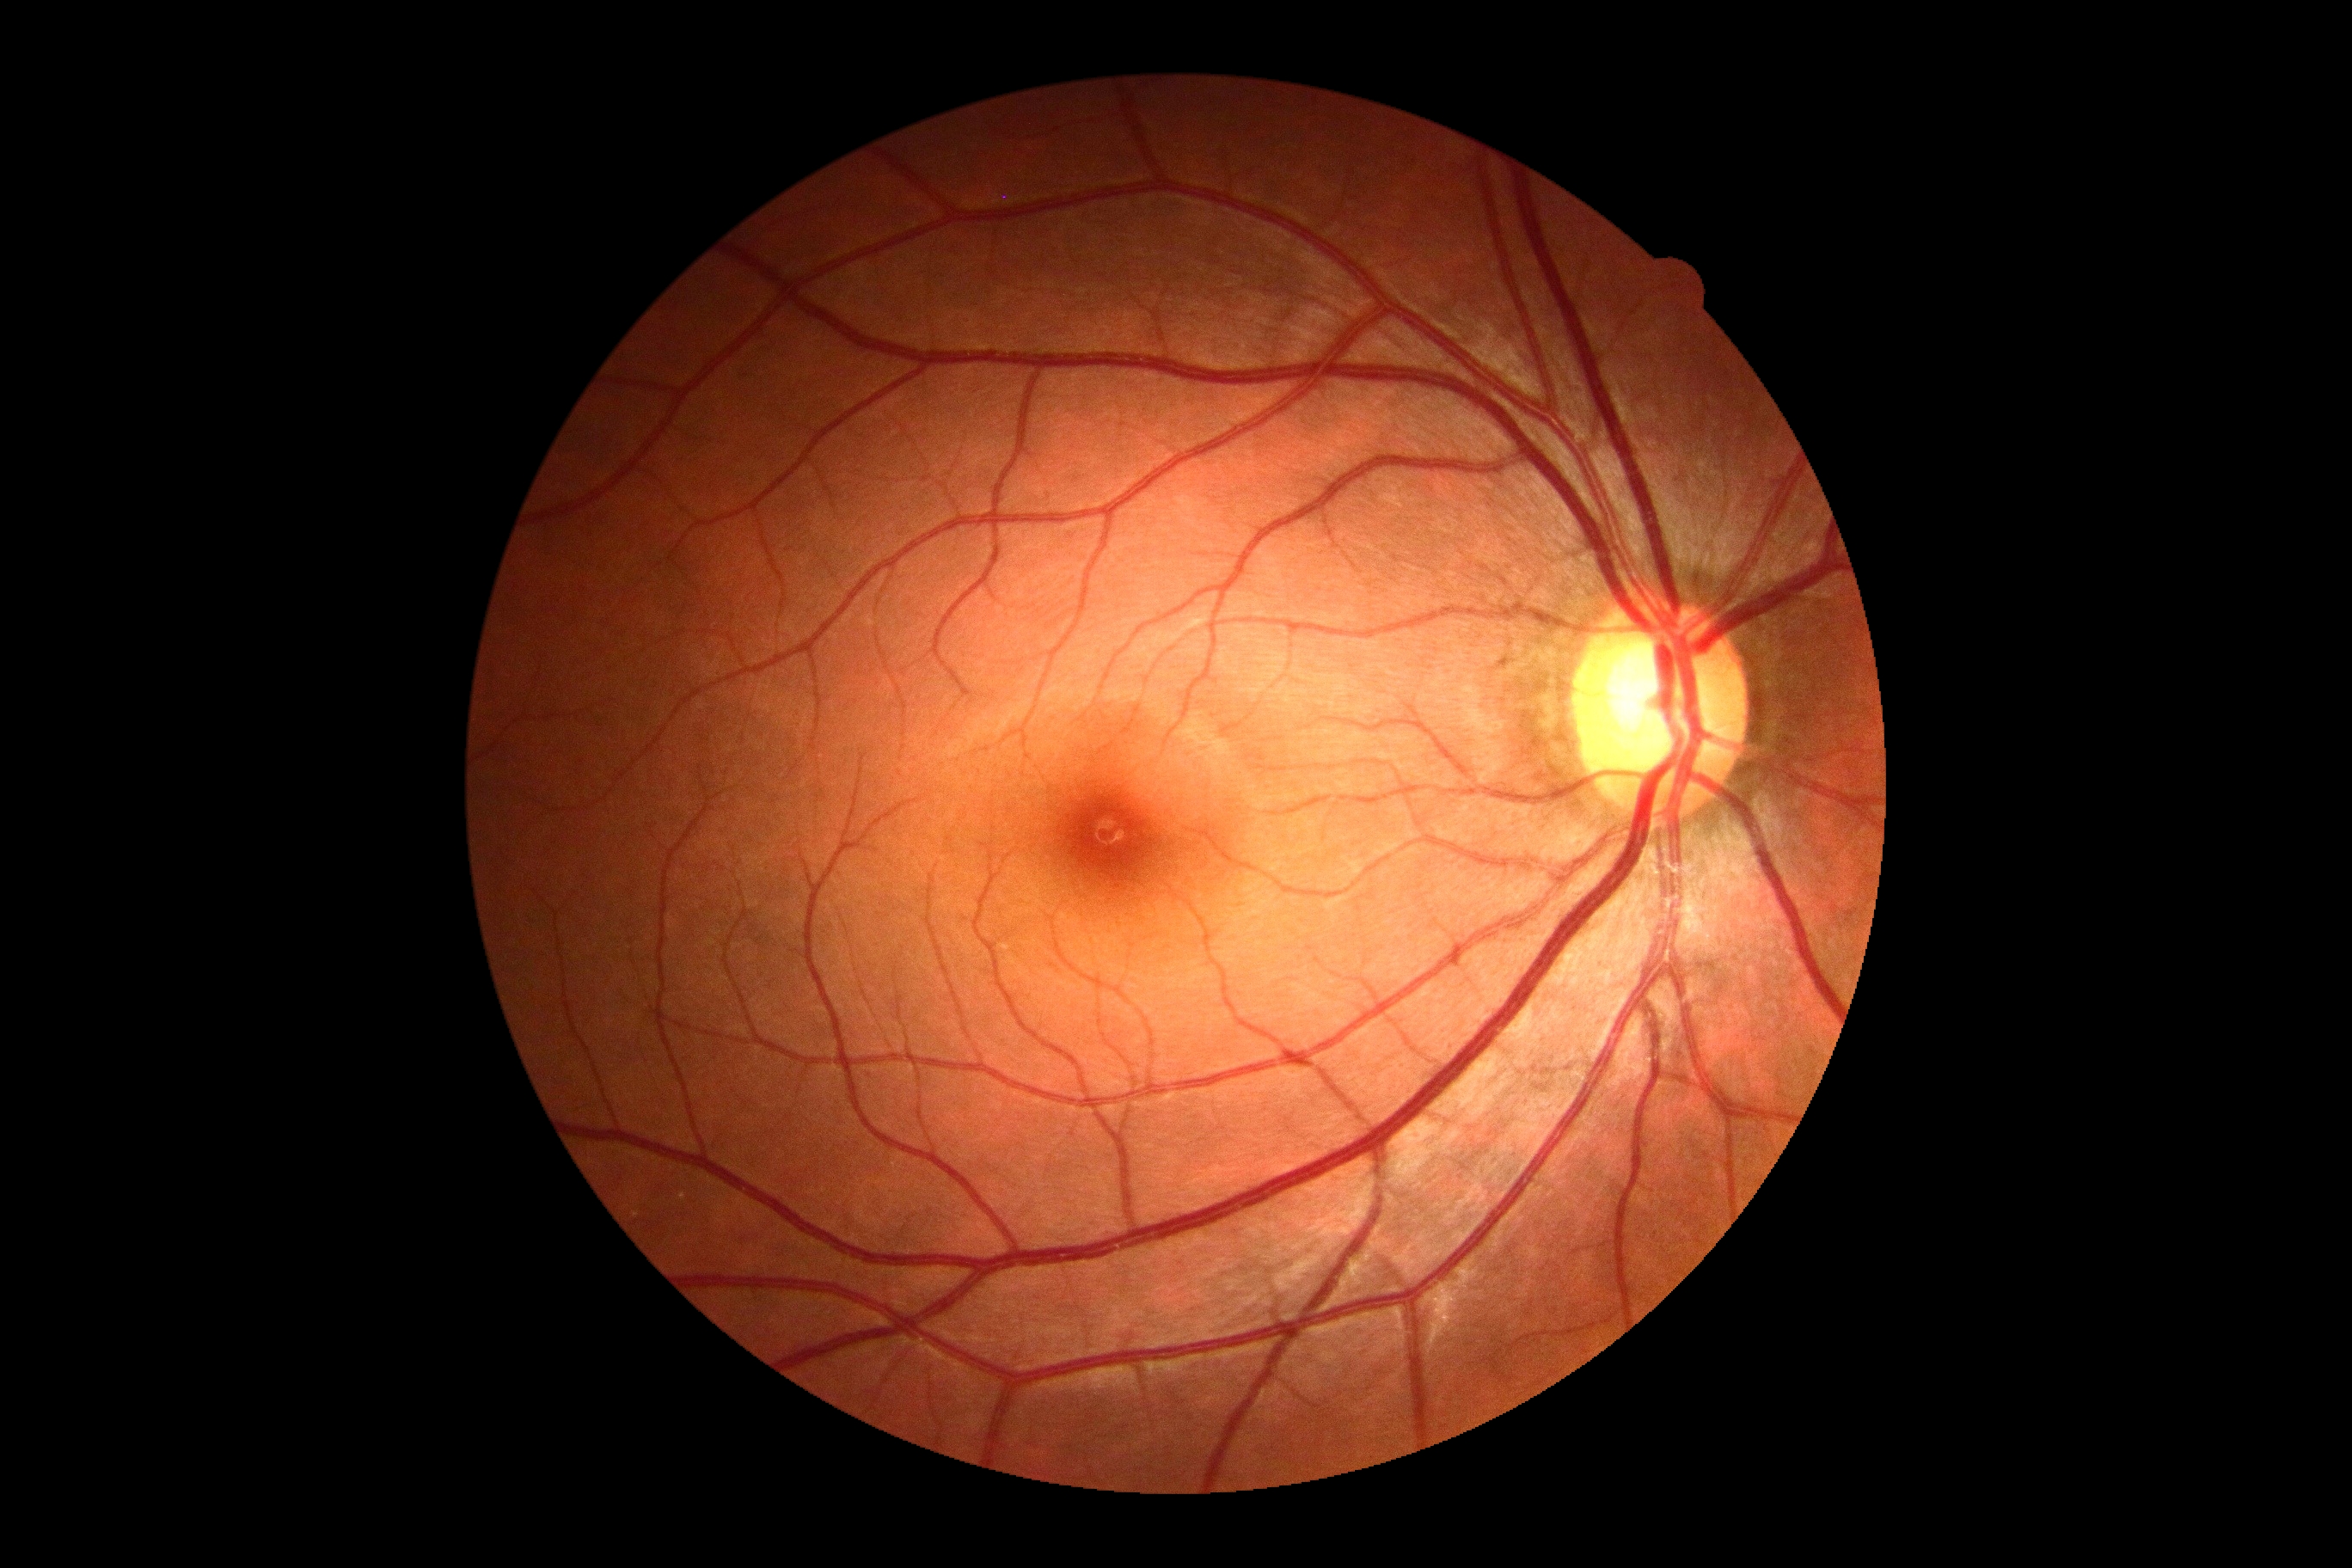 No DR findings. DR severity is grade 0 (no apparent retinopathy) — no visible signs of diabetic retinopathy.